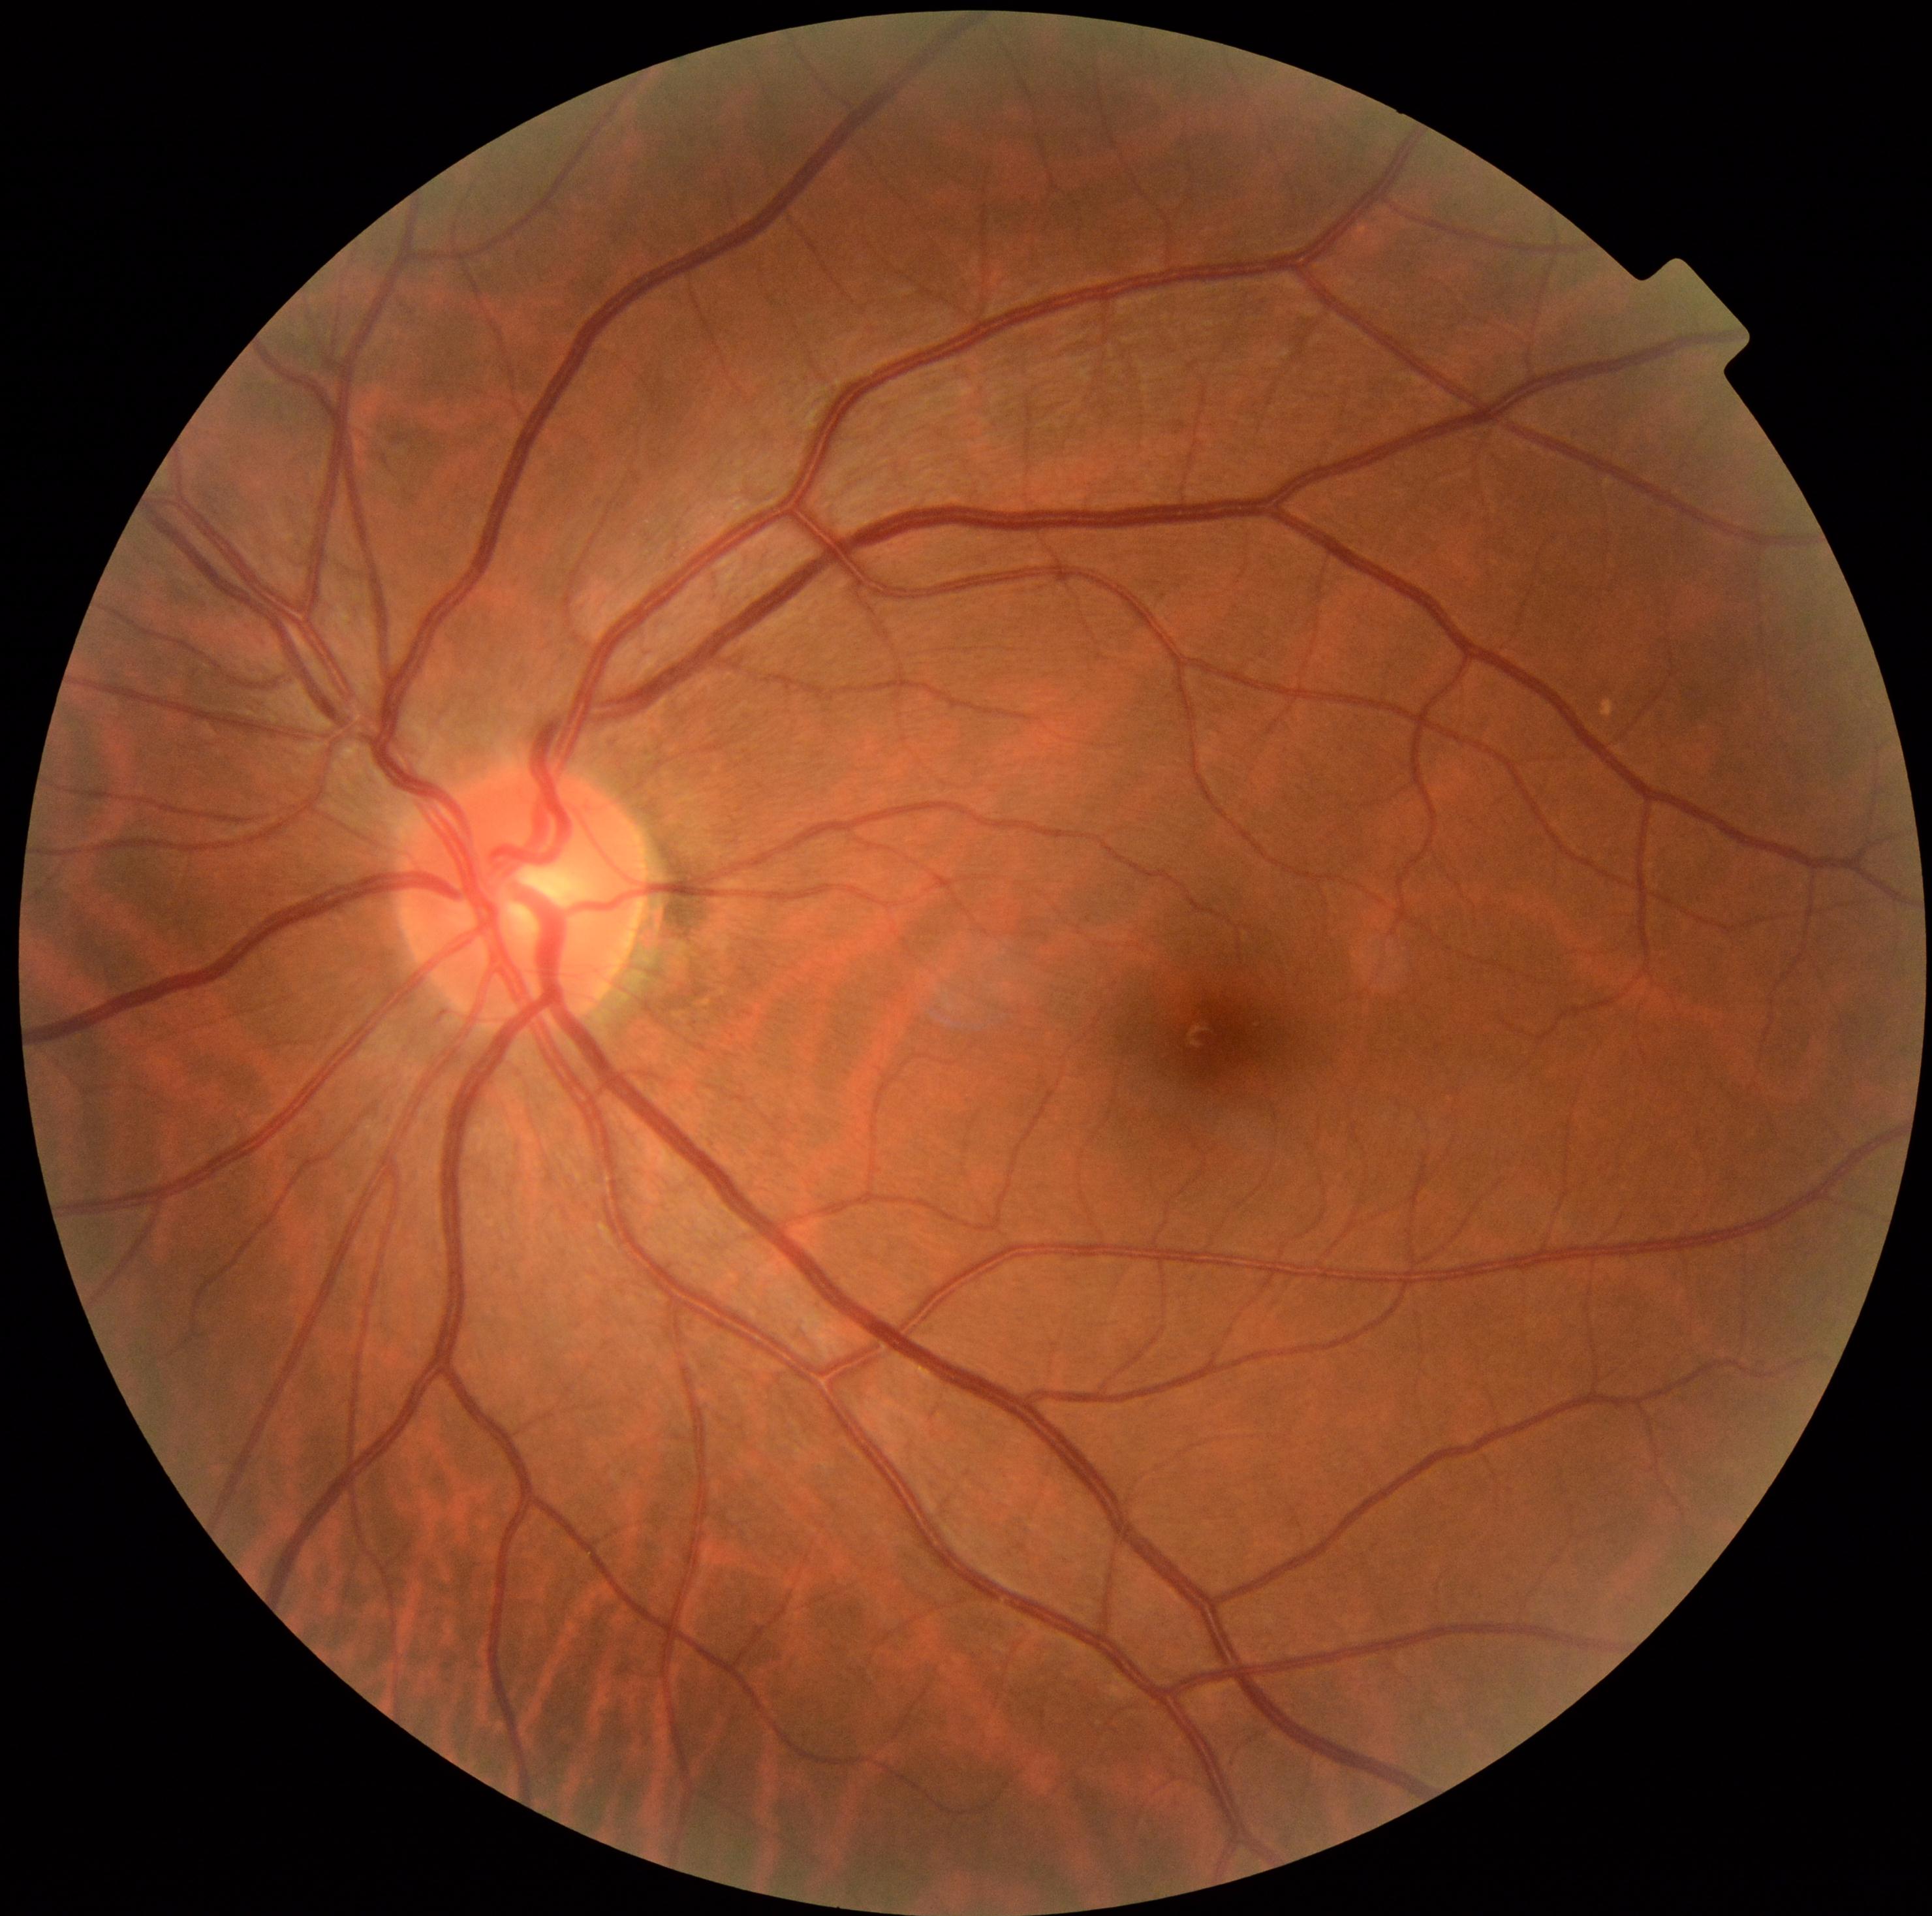 diabetic retinopathy severity@0.